1924x1556px; ultra-widefield (UWF) fundus image; 200° field of view.
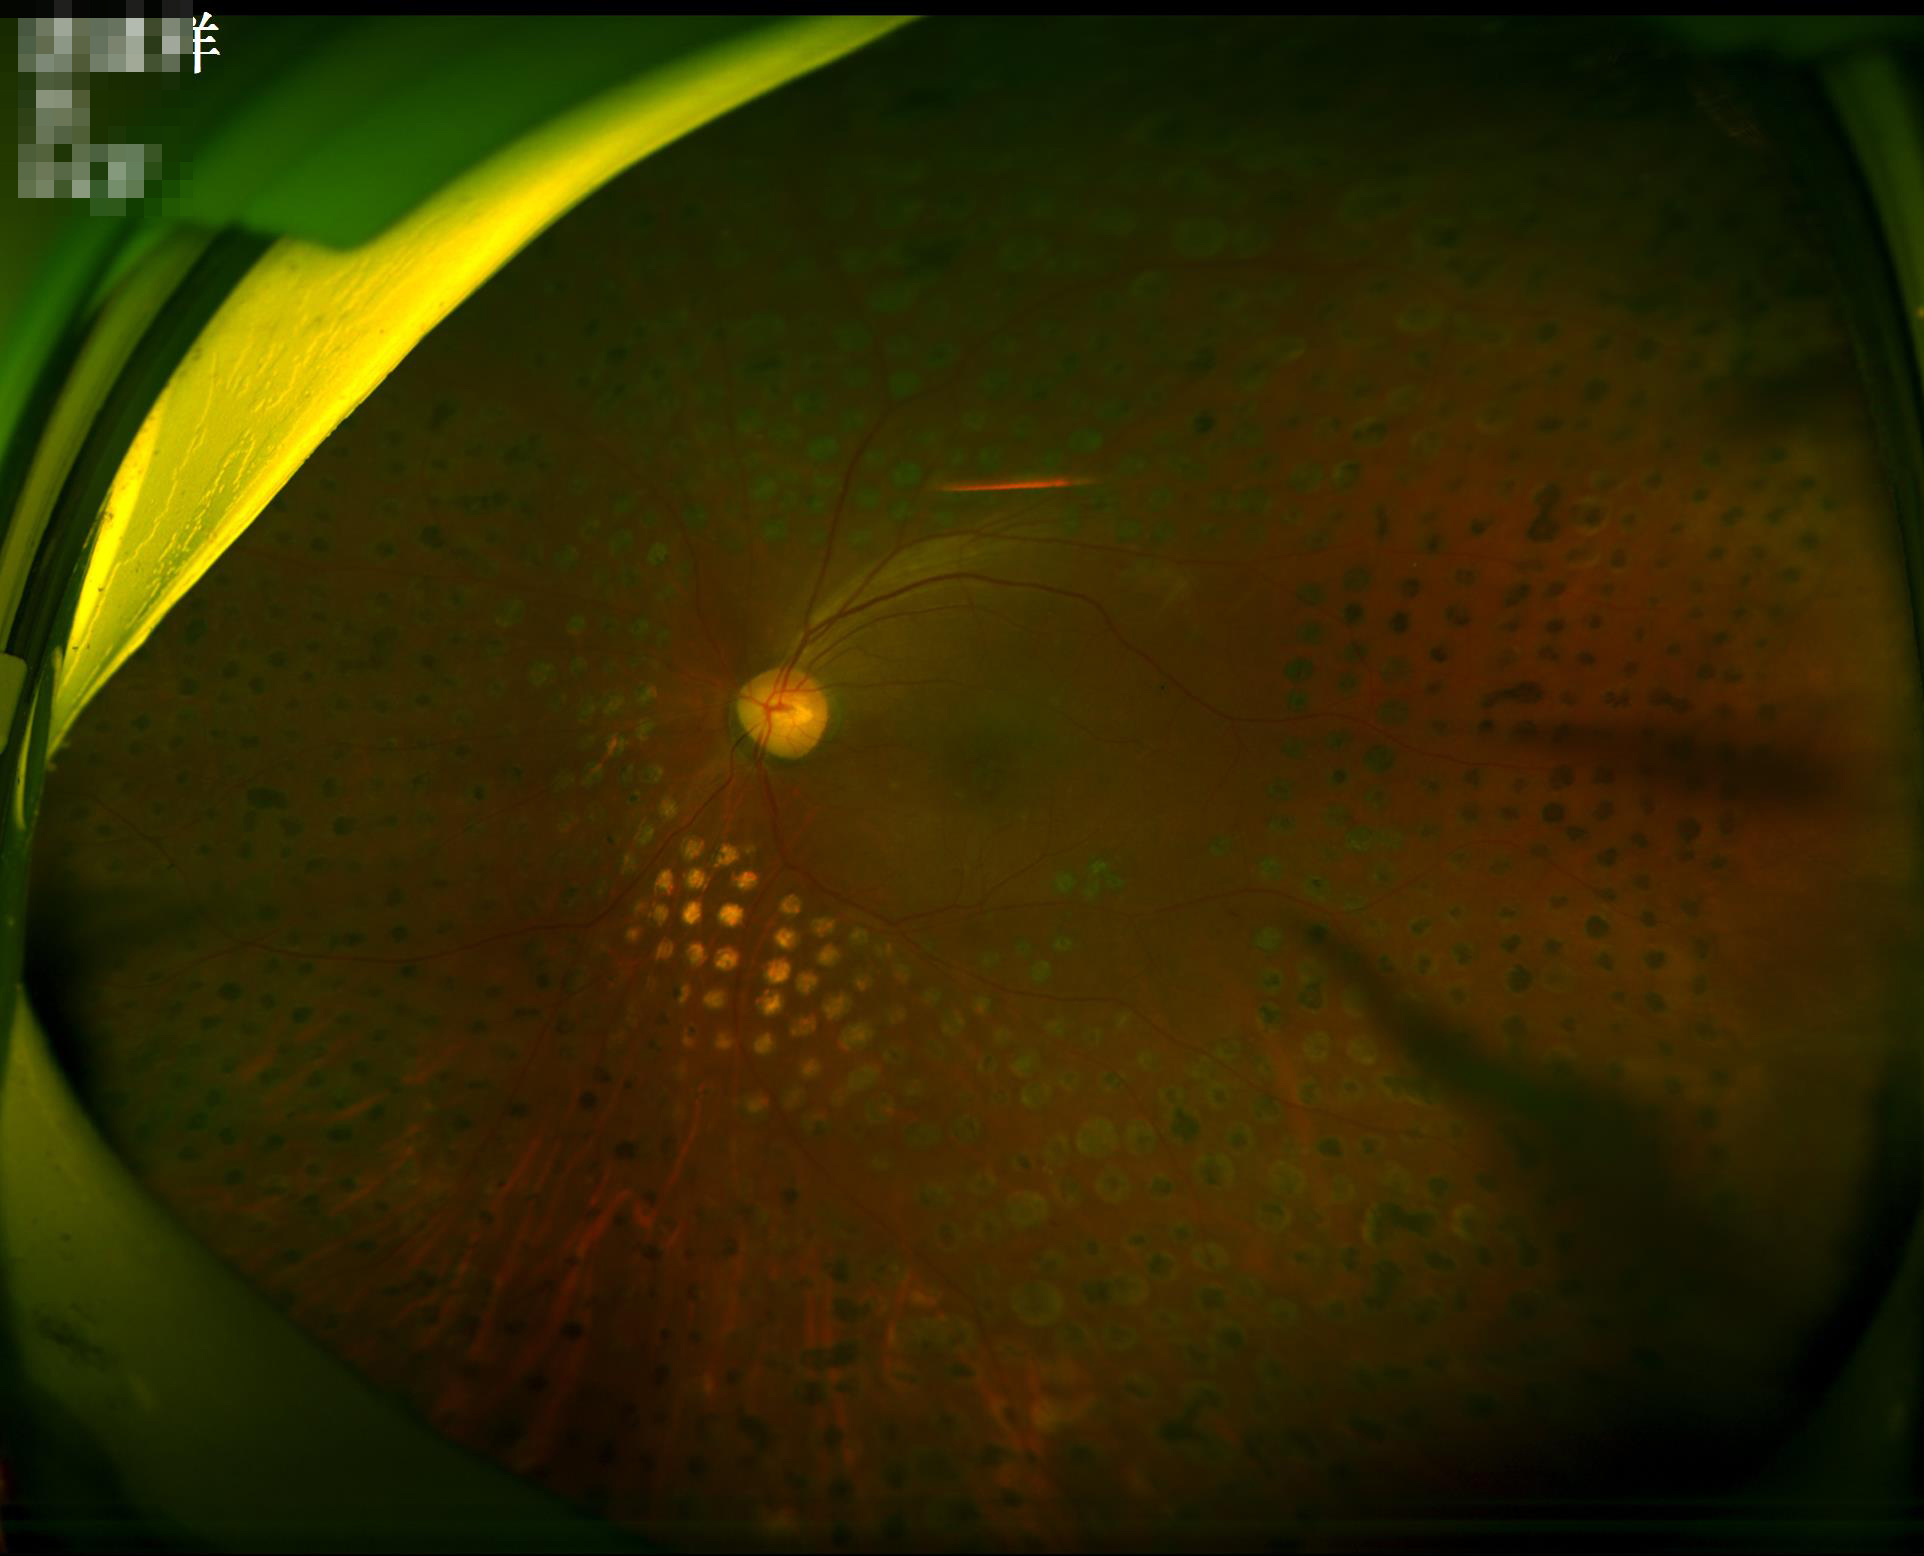
Illumination is uneven. Adequate contrast for distinguishing structures. No noticeable blur. Acceptable image quality.